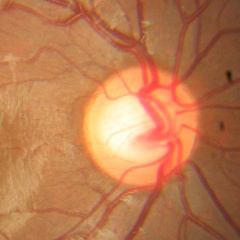
Optic disc photograph demonstrating no glaucoma.